45° field of view · 2184 x 1690 pixels:
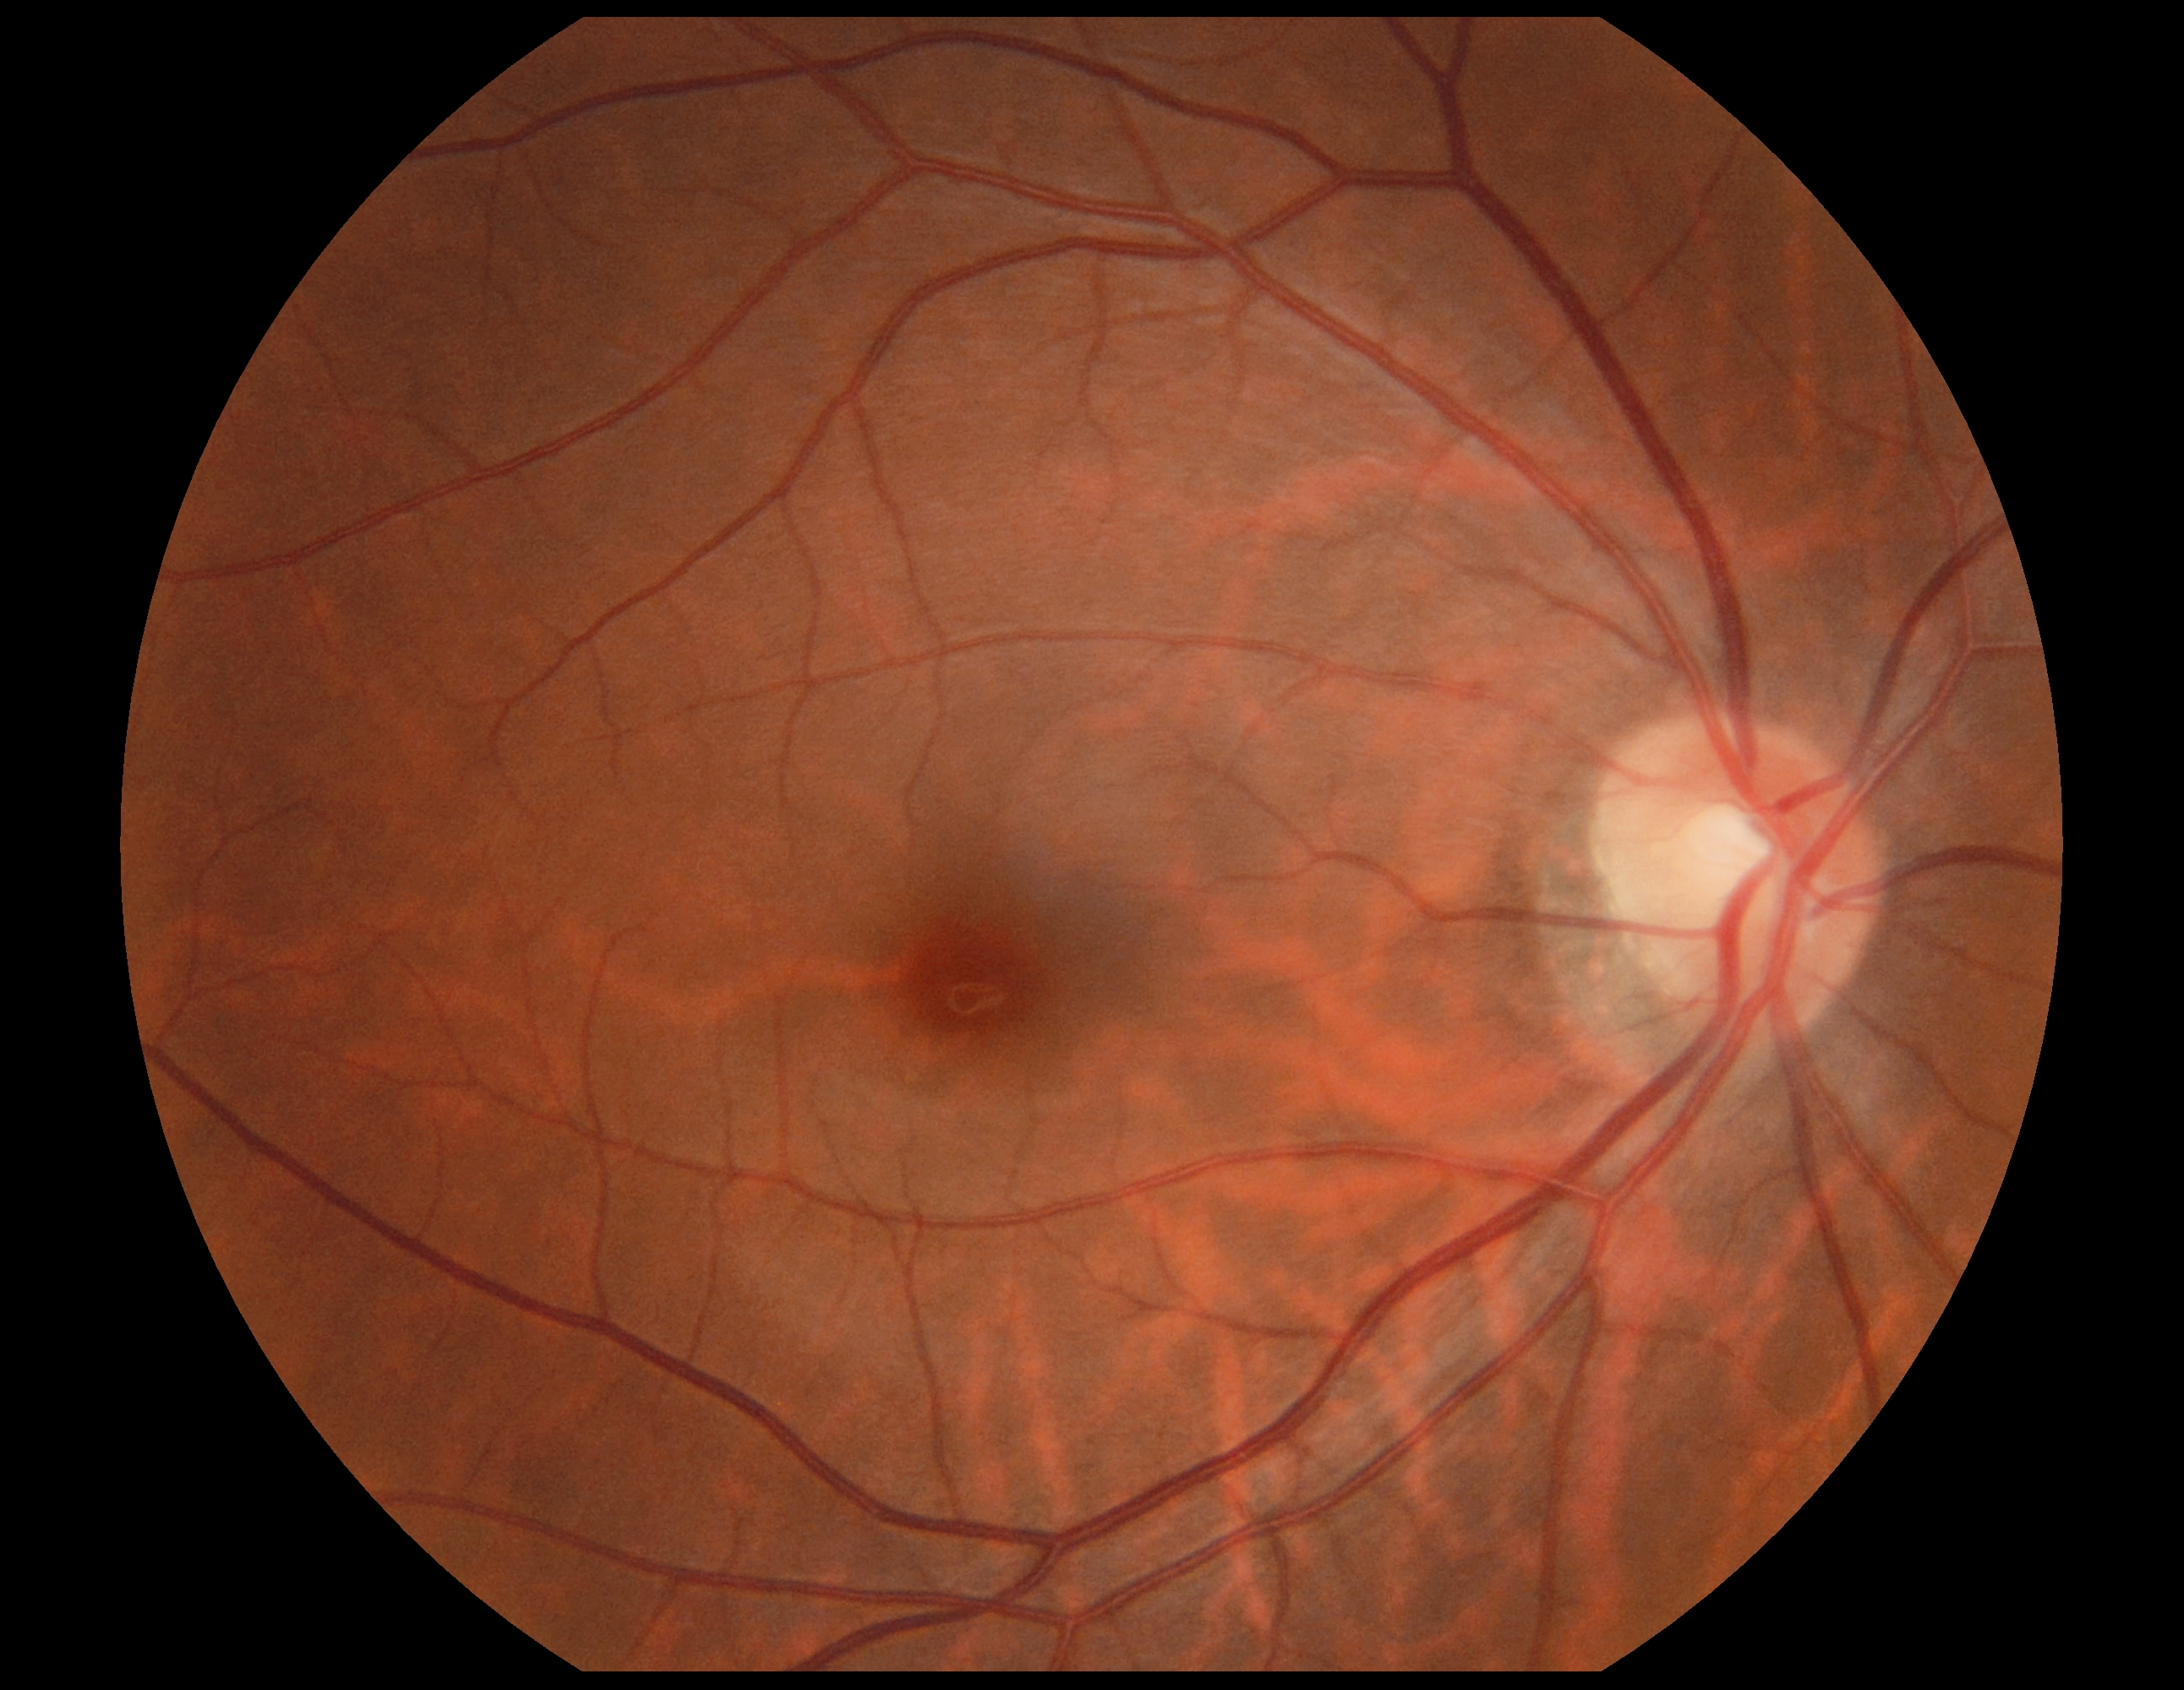
DR: no apparent retinopathy (grade 0).